Retinal fundus photograph, nonmydriatic fundus photograph, 45-degree field of view — 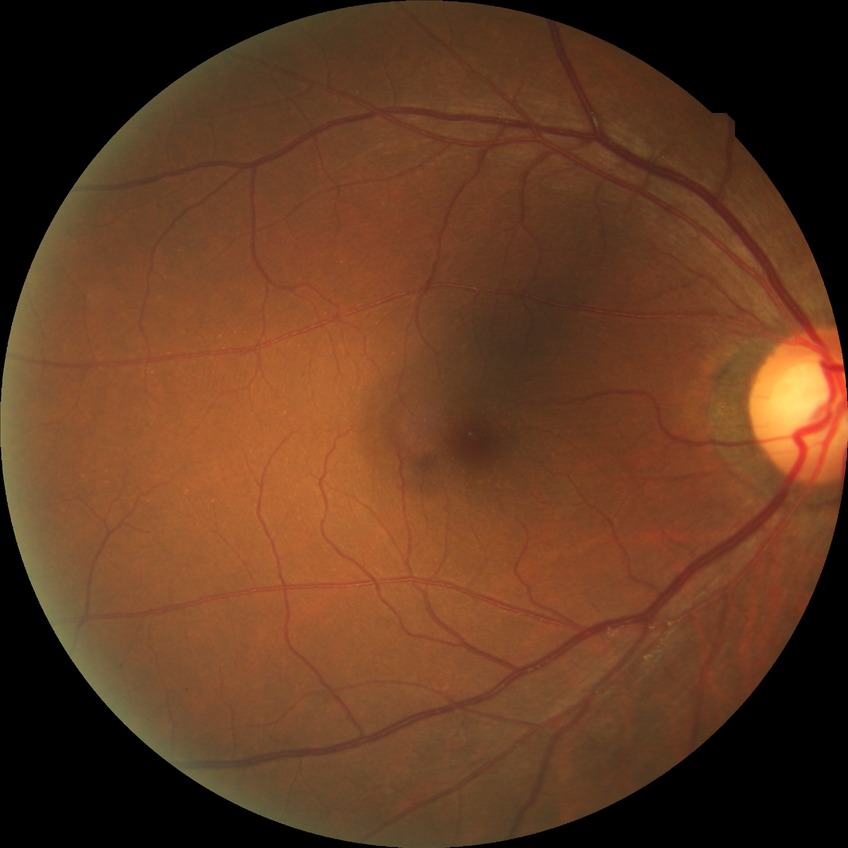

– Davis DR grade: NDR